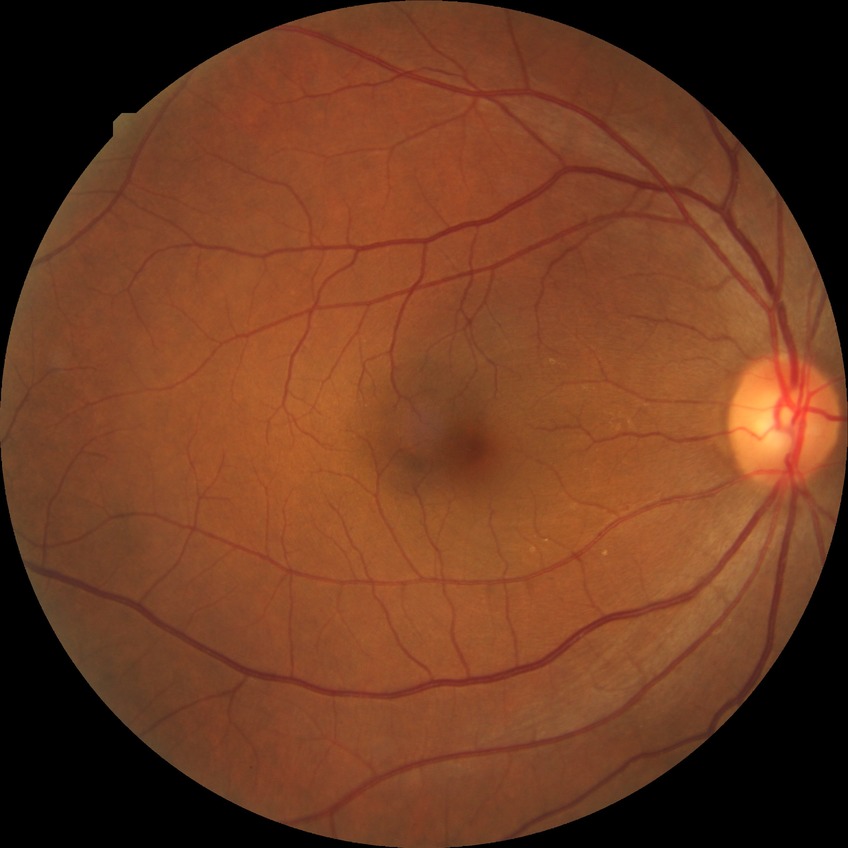   davis_grade: NDR (no diabetic retinopathy)